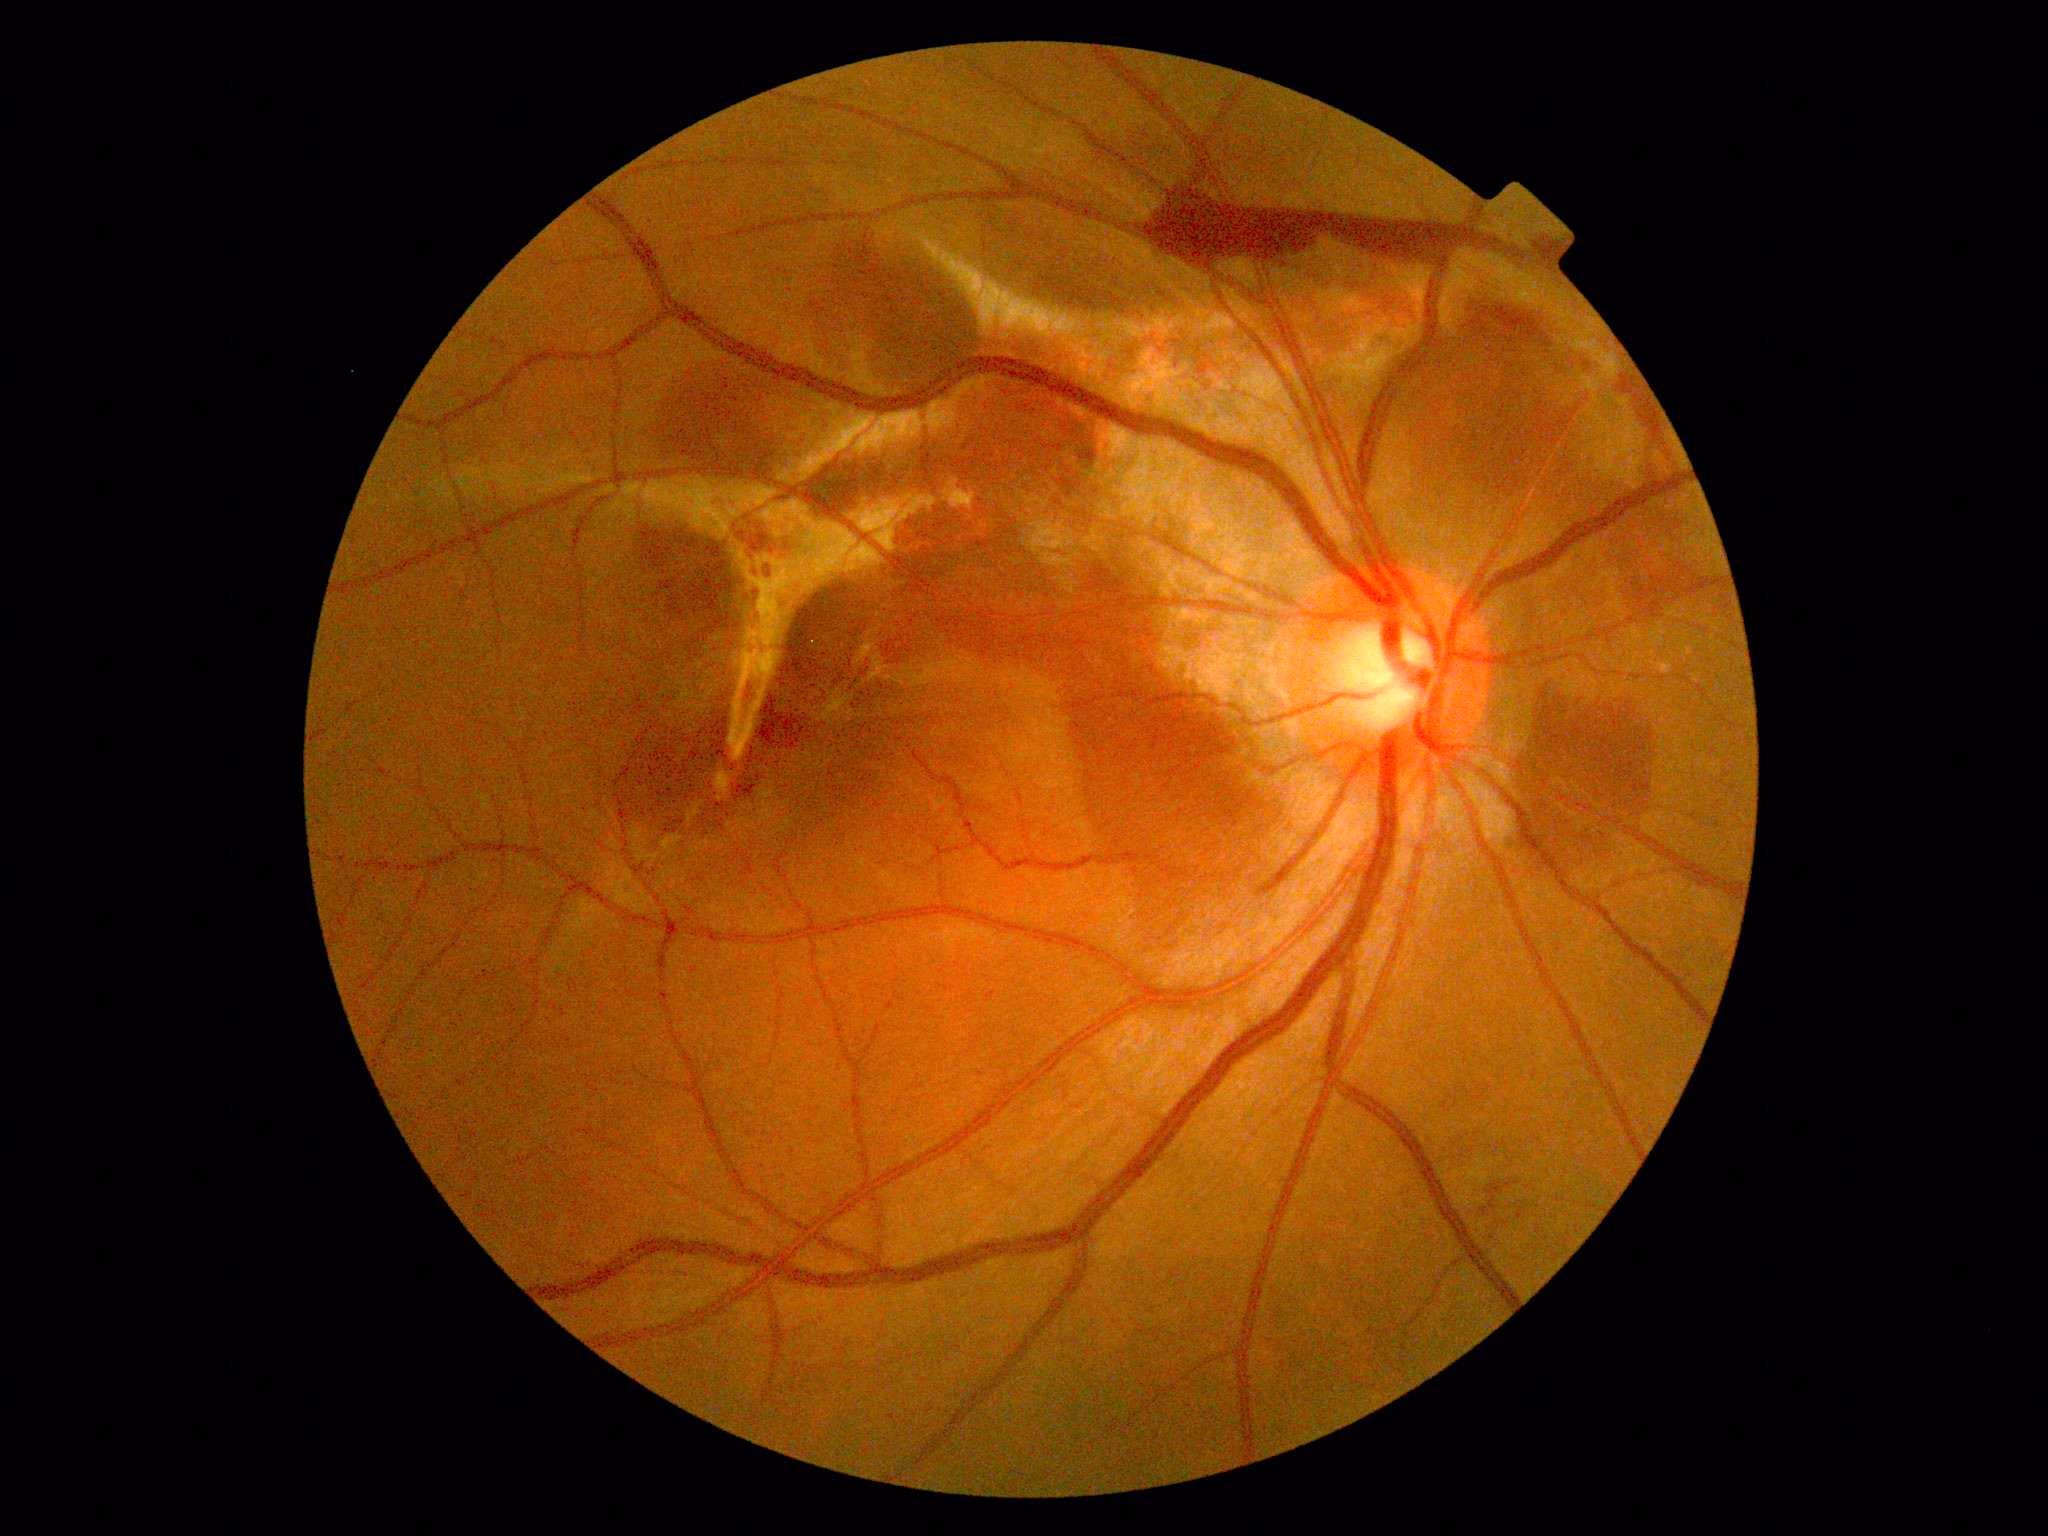
DR severity: grade 4 (PDR).